Wide-field fundus photograph of an infant — 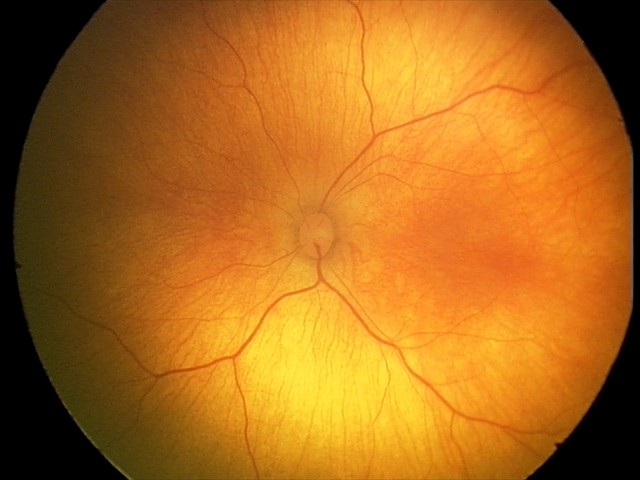

Screening examination diagnosed as physiological.